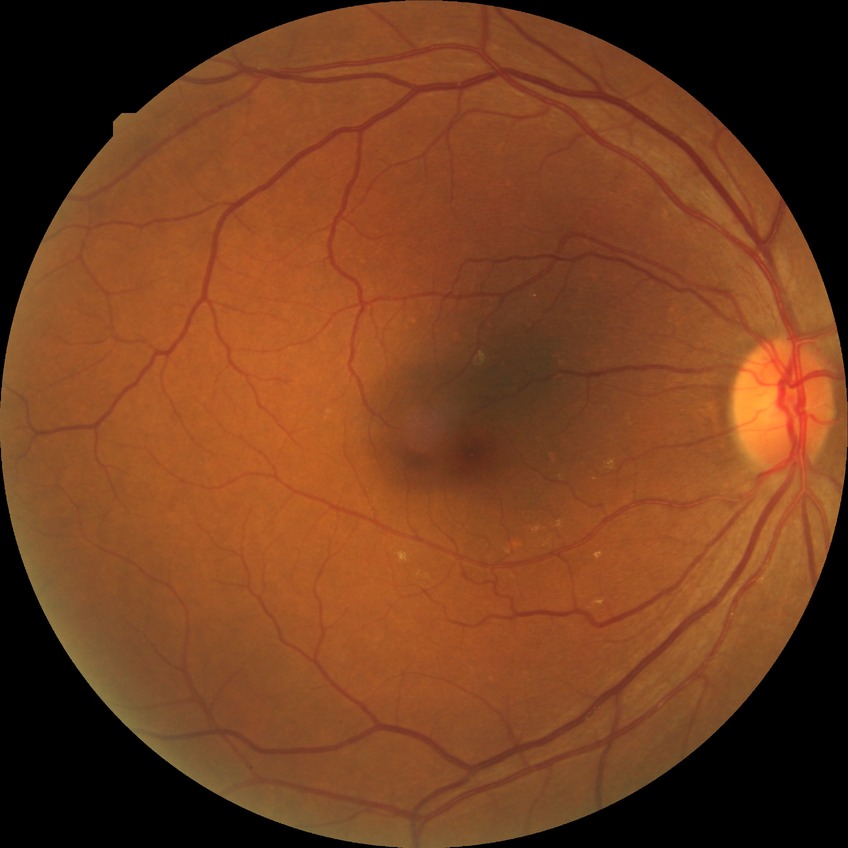 Diabetic retinopathy grade is no diabetic retinopathy.